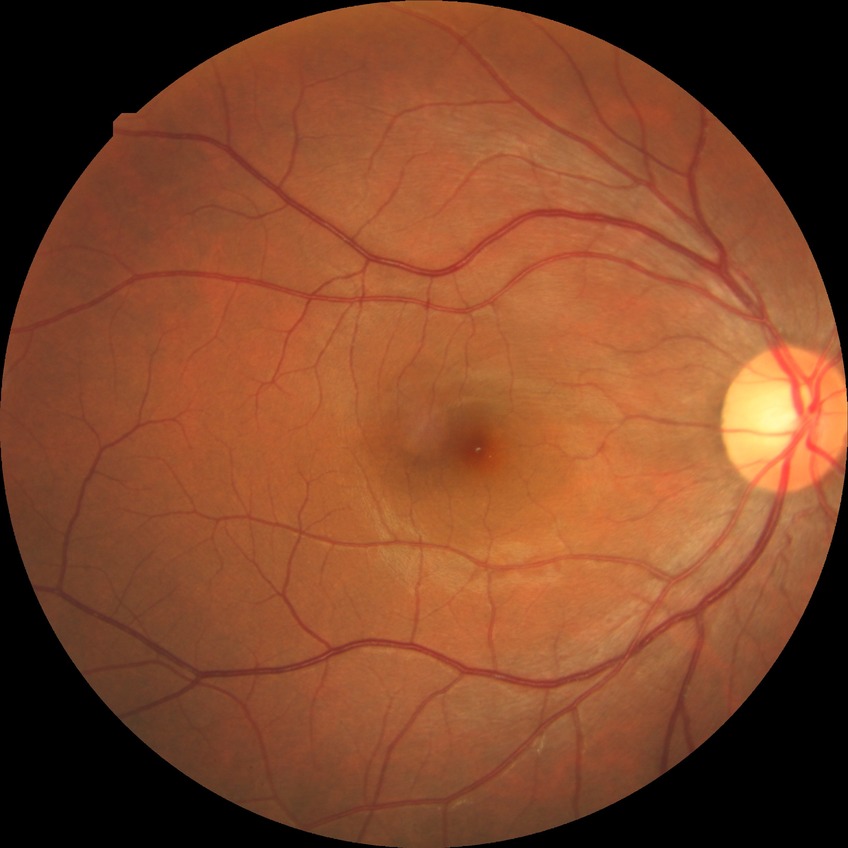 Diabetic retinopathy (DR) is no diabetic retinopathy (NDR).